Fundus photo, FOV: 45 degrees, 2212 x 1659 pixels:
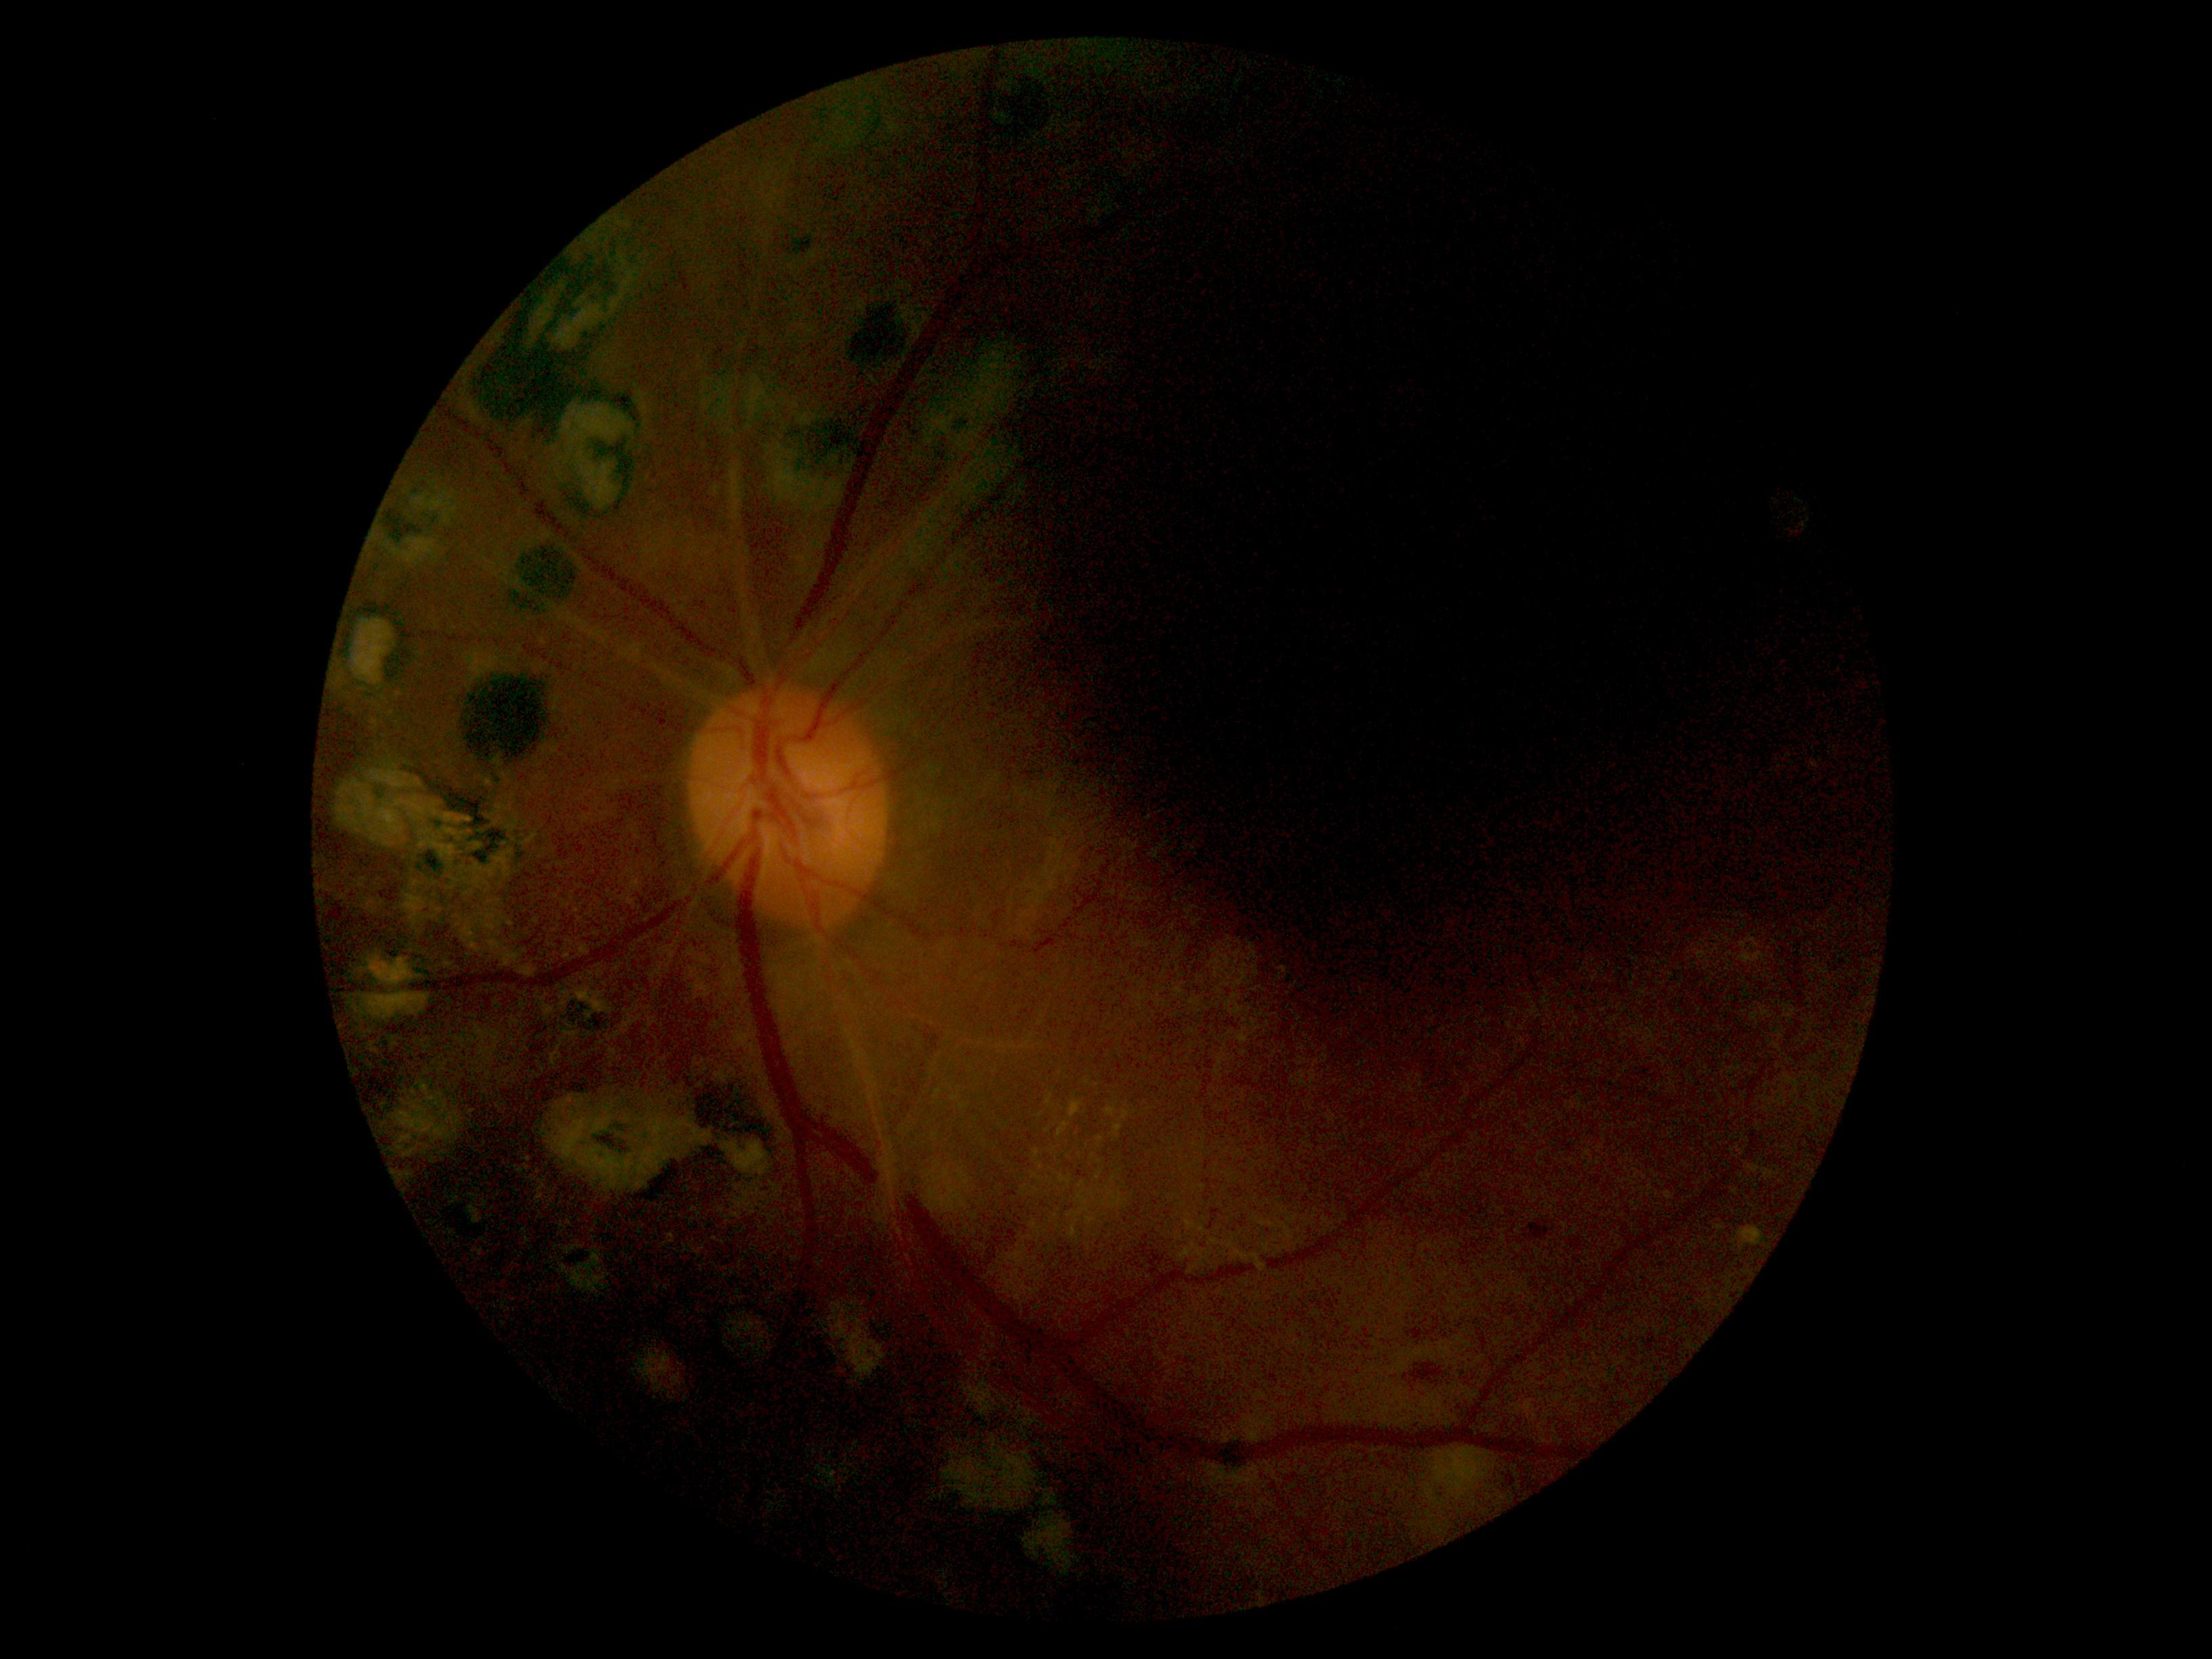

The retinopathy is classified as non-proliferative diabetic retinopathy. Diabetic retinopathy (DR): grade 2 (moderate NPDR).